CFP.
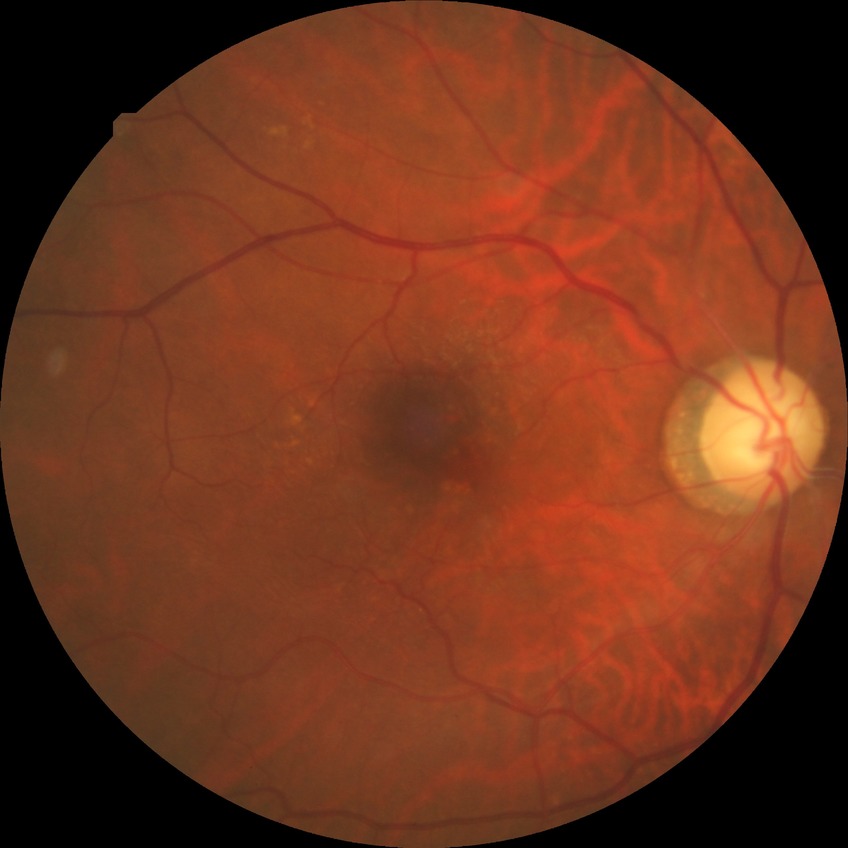
Diabetic retinopathy (DR) is NDR (no diabetic retinopathy).